Retinal fundus photograph. Modified Davis grading. NIDEK AFC-230. 45° FOV.
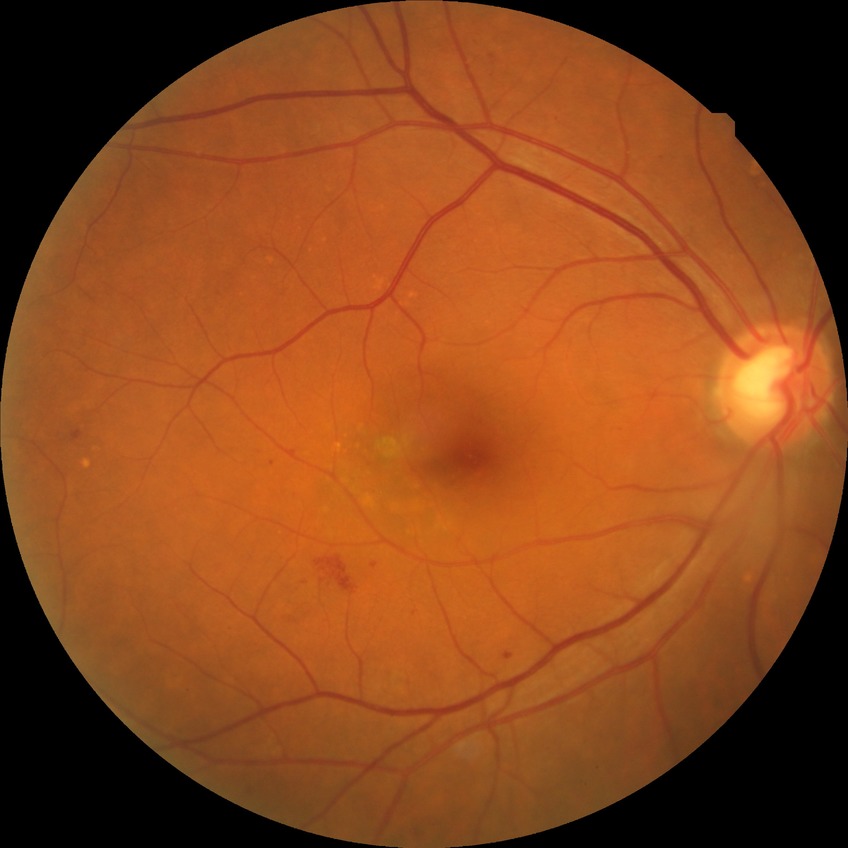 Retinopathy grade: simple diabetic retinopathy.